Acquired on the Clarity RetCam 3. Infant wide-field fundus photograph
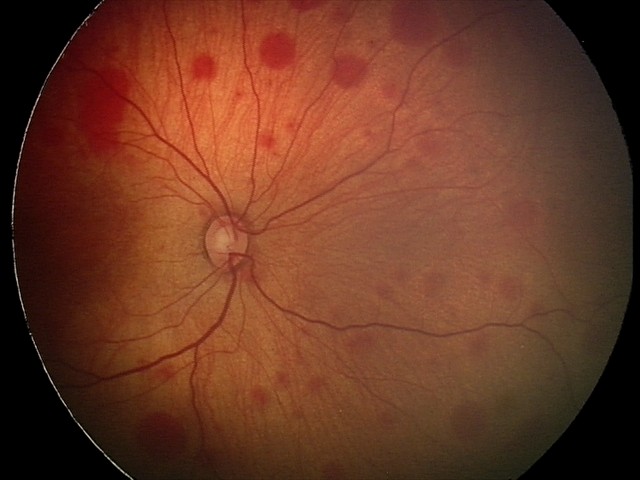 Diagnosis from this screening exam: retinal hemorrhages.